1659x2212px. Color fundus image
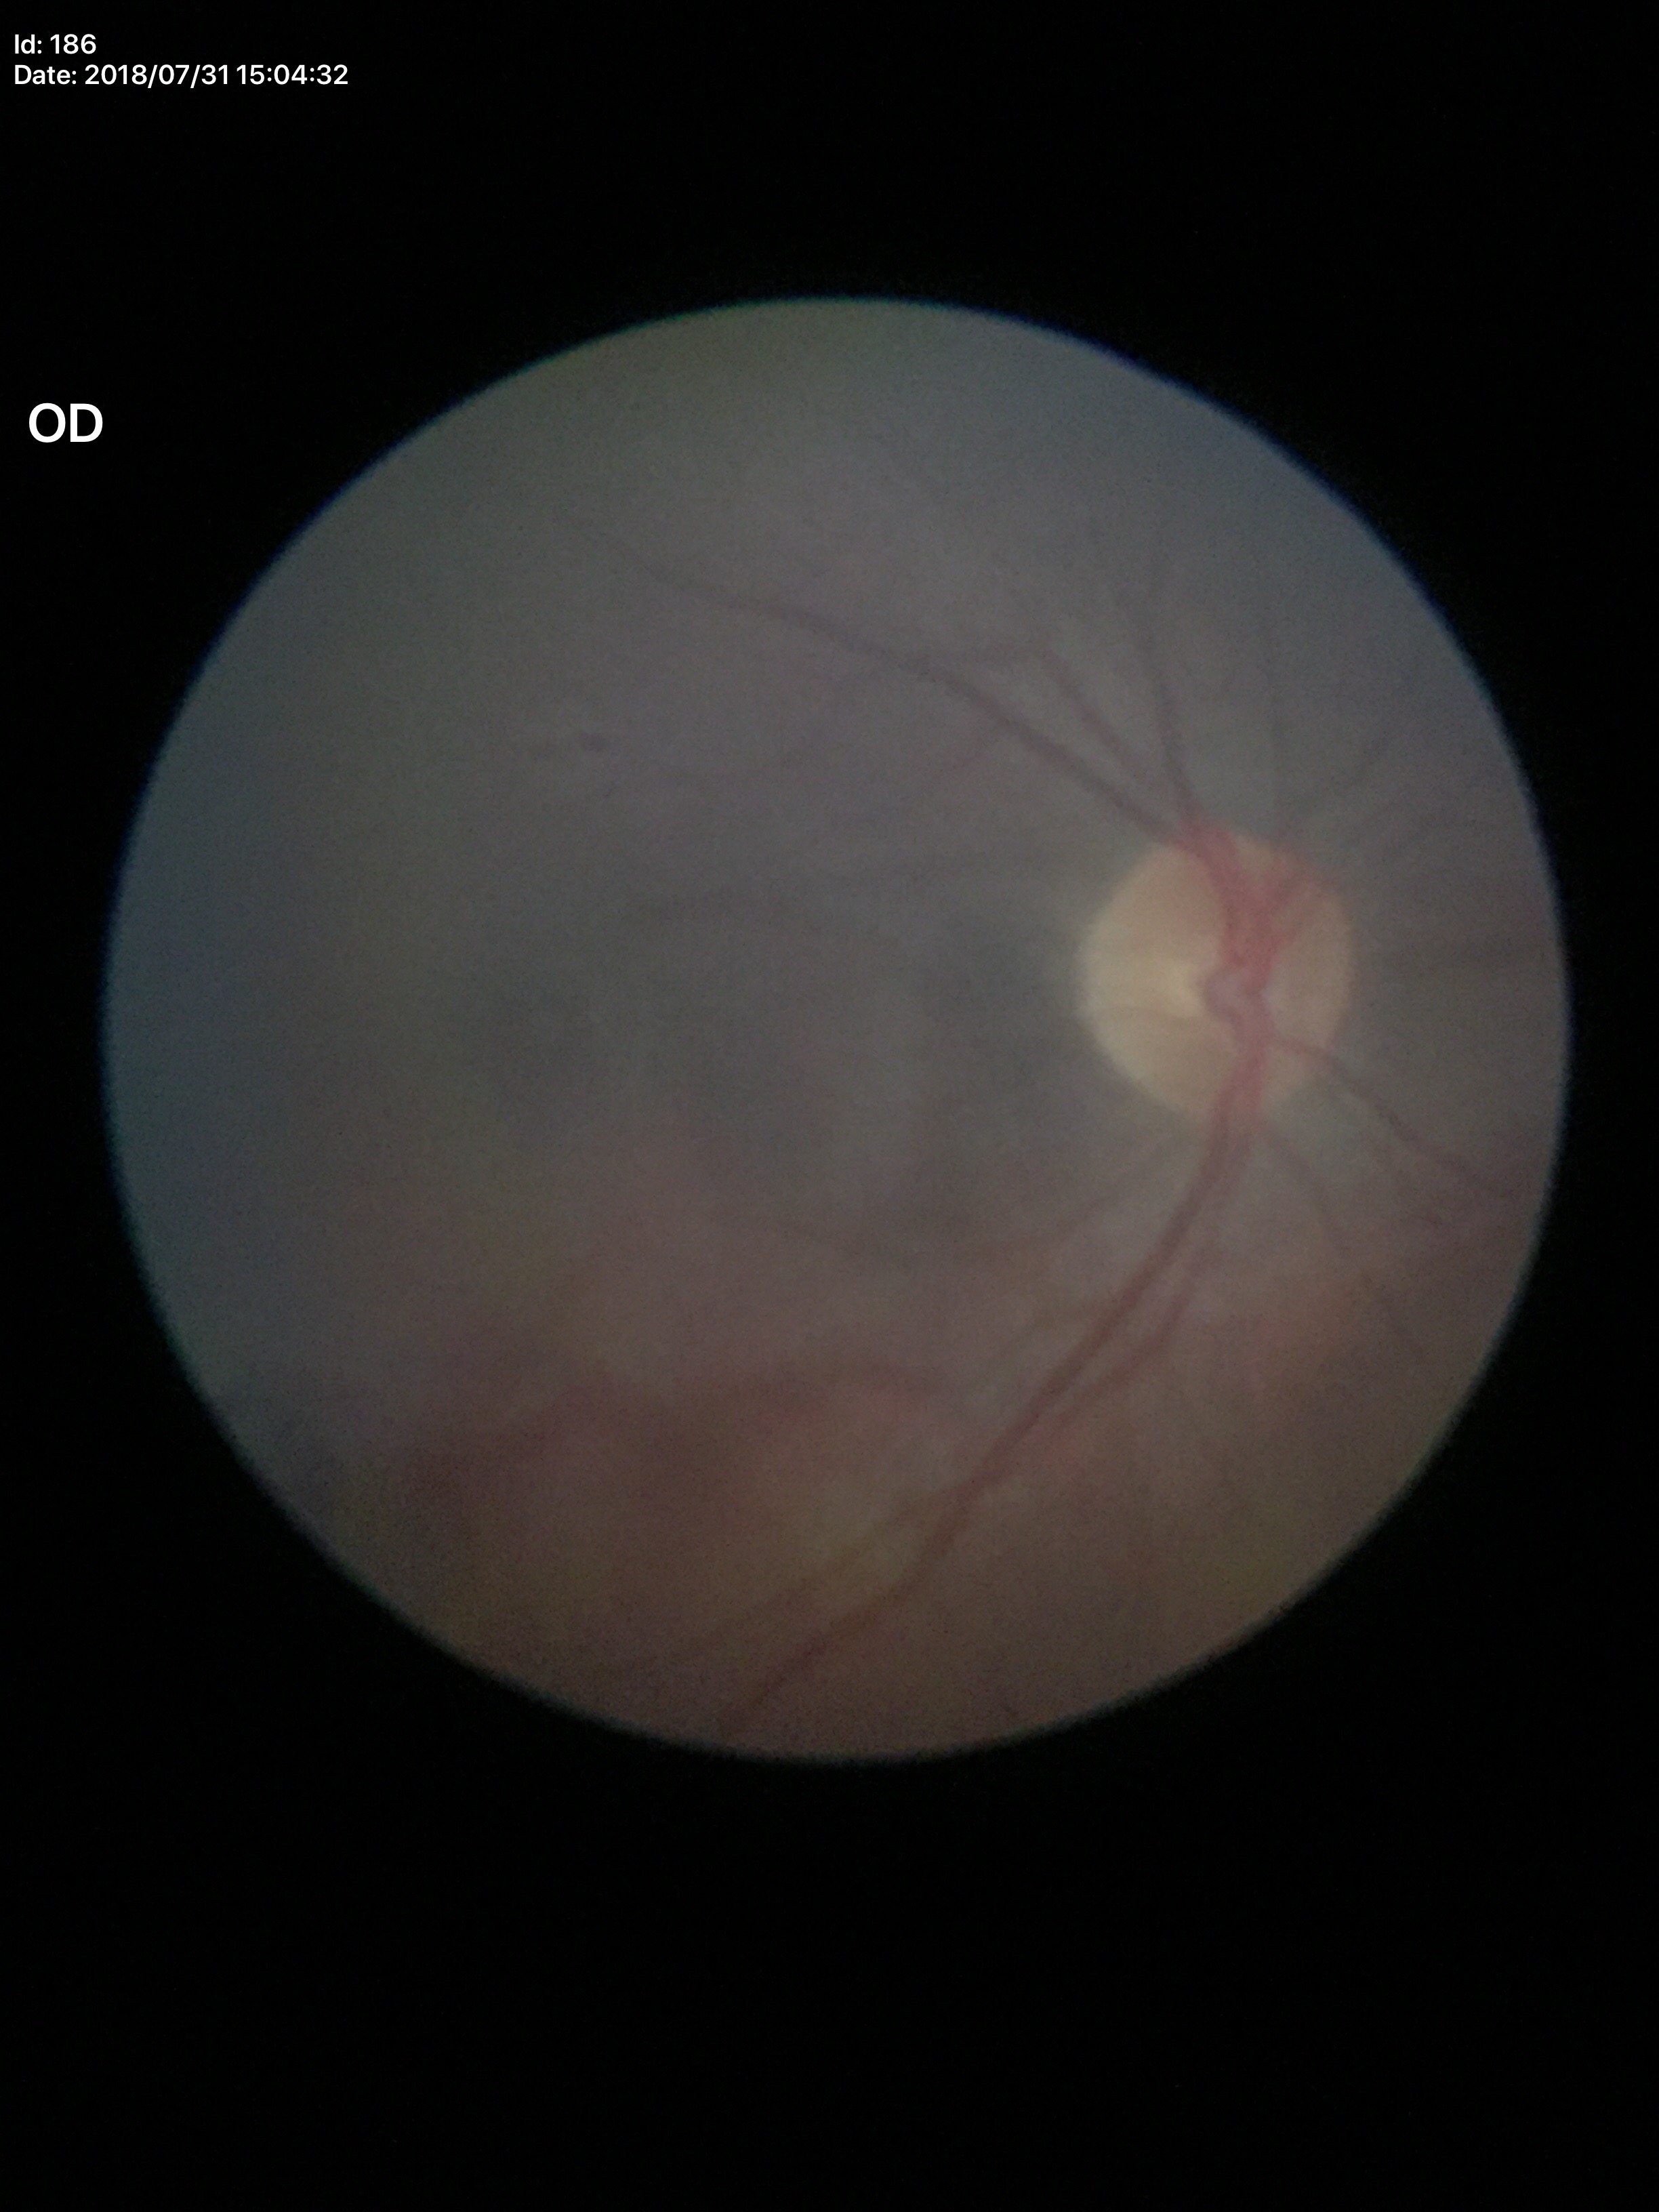 Glaucoma impression = negative (1/5 graders called glaucoma suspect), vertical C/D ratio = 0.43, horizontal C/D ratio = 0.48.